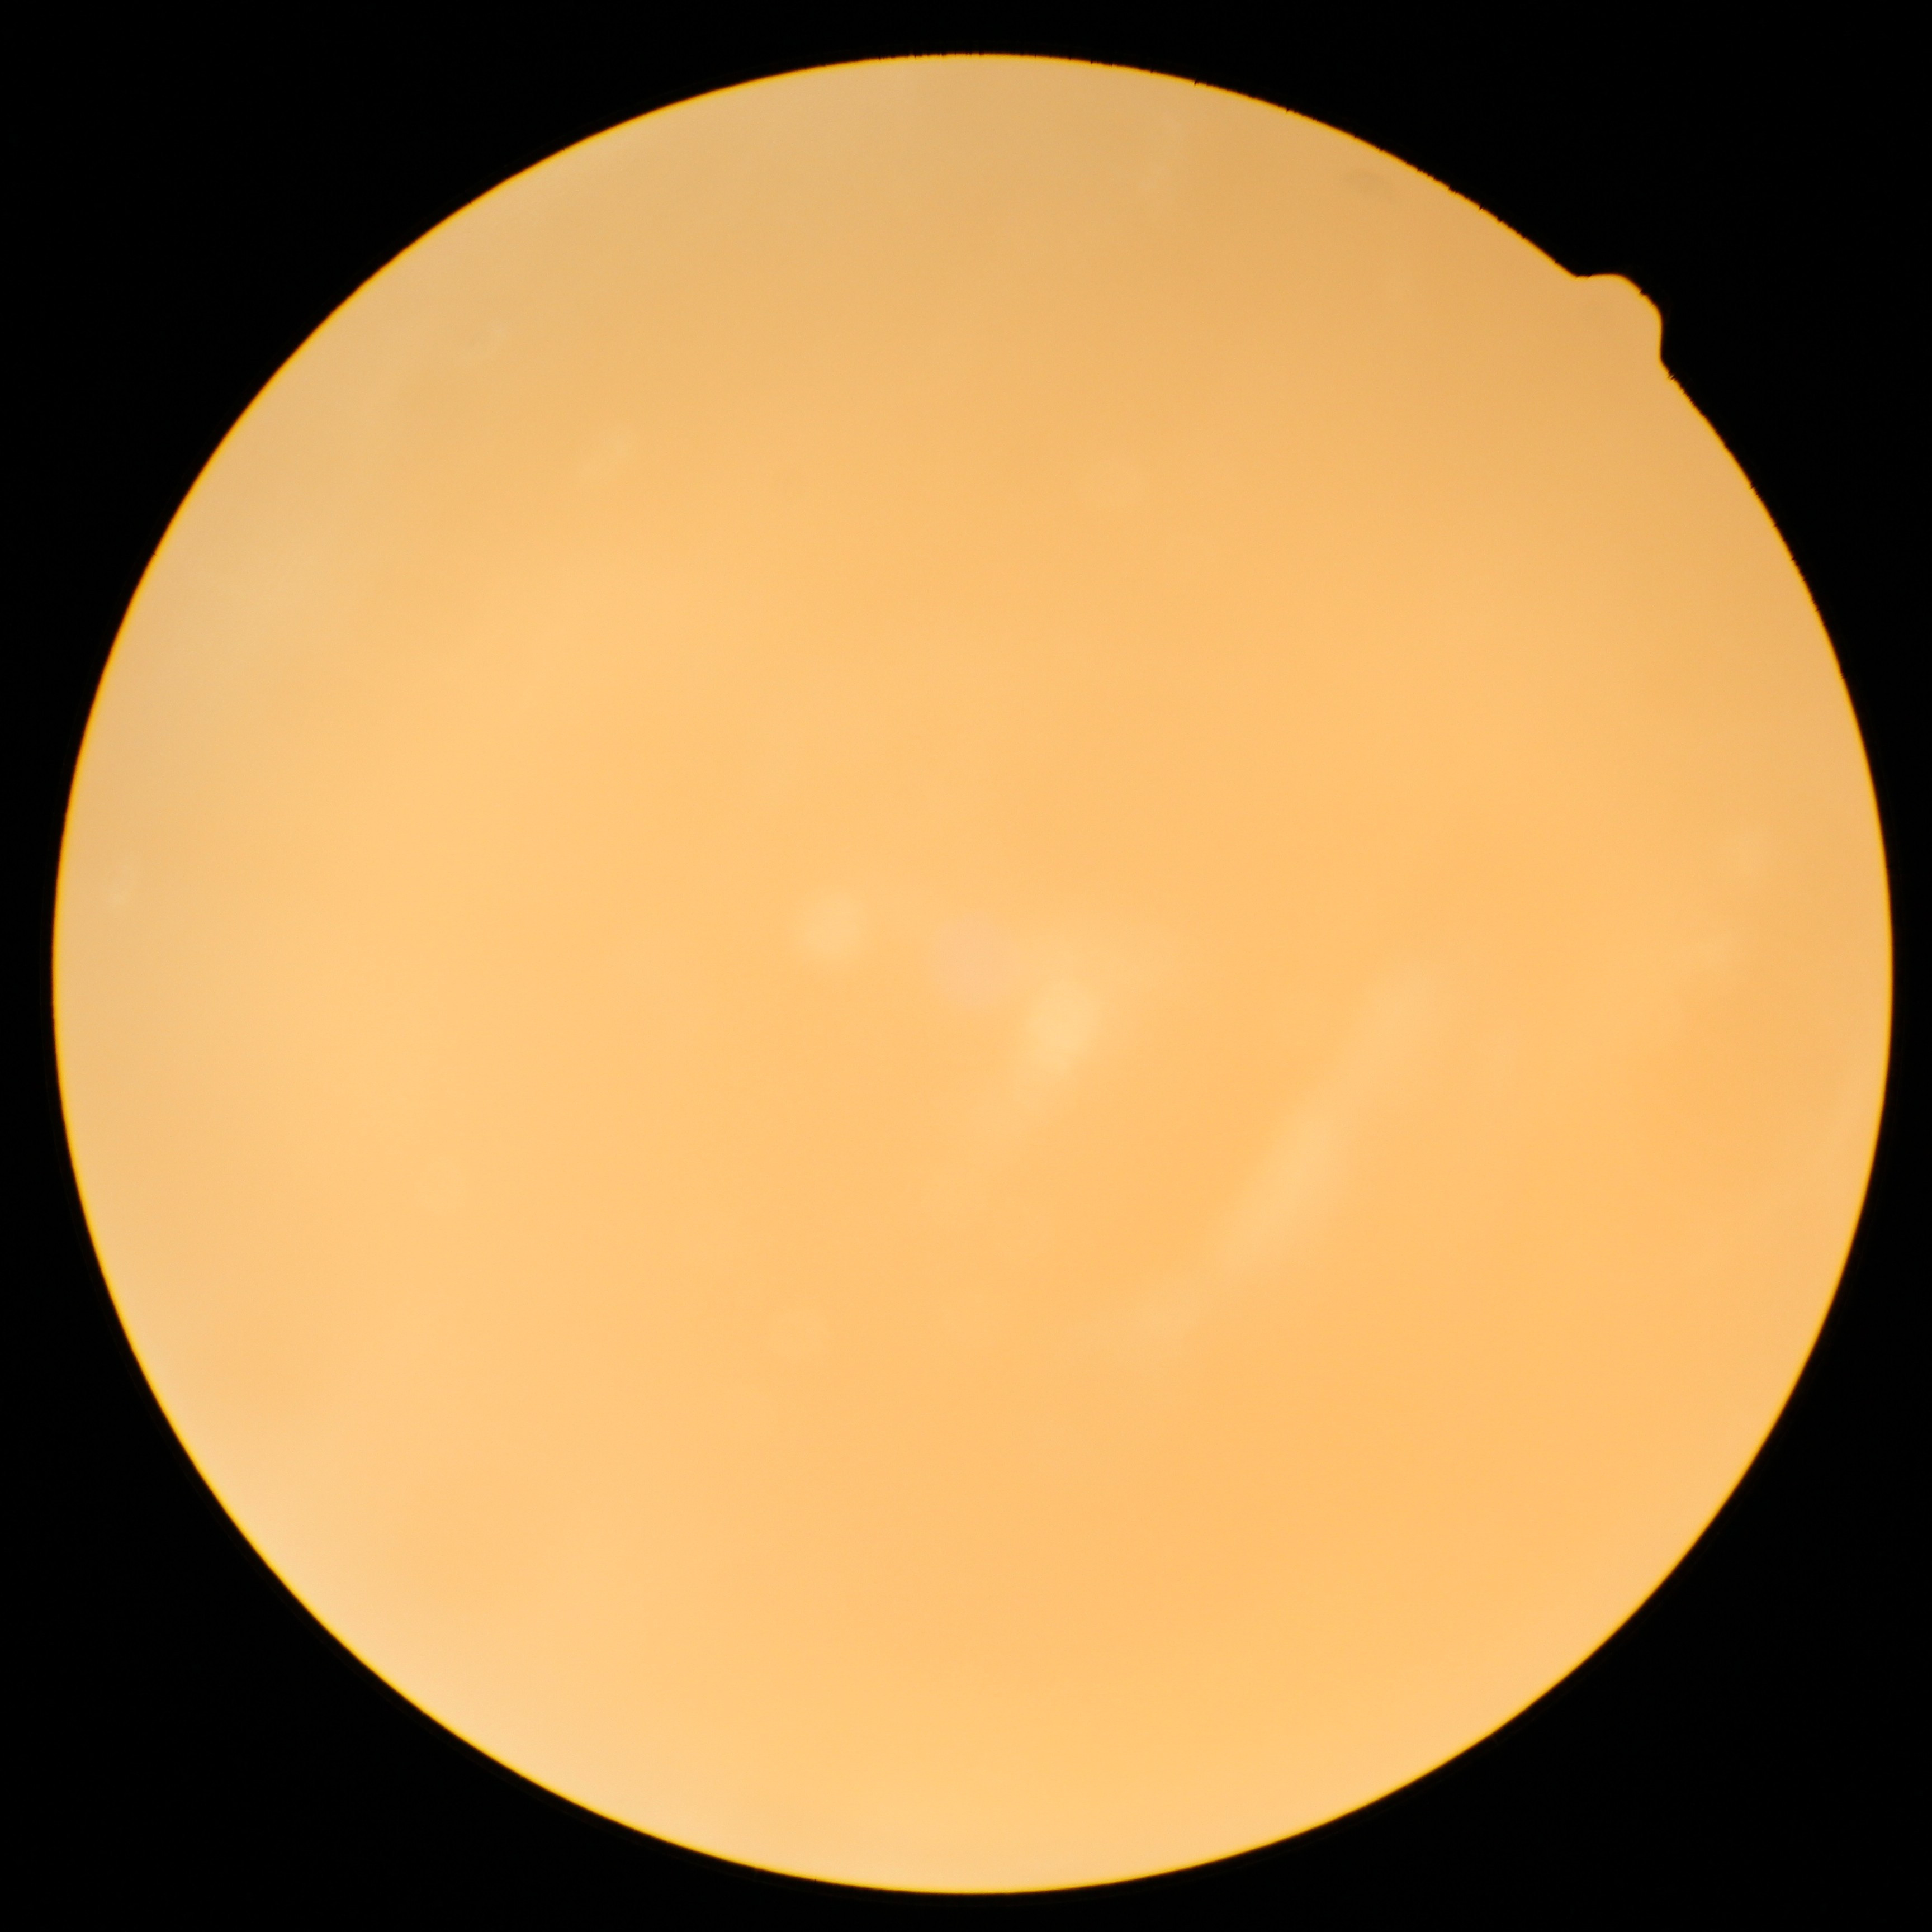

  dr_grade: ungradable due to poor image quality
  quality: below grading threshold